FOV: 45 degrees, CFP, image size 2352x1568:
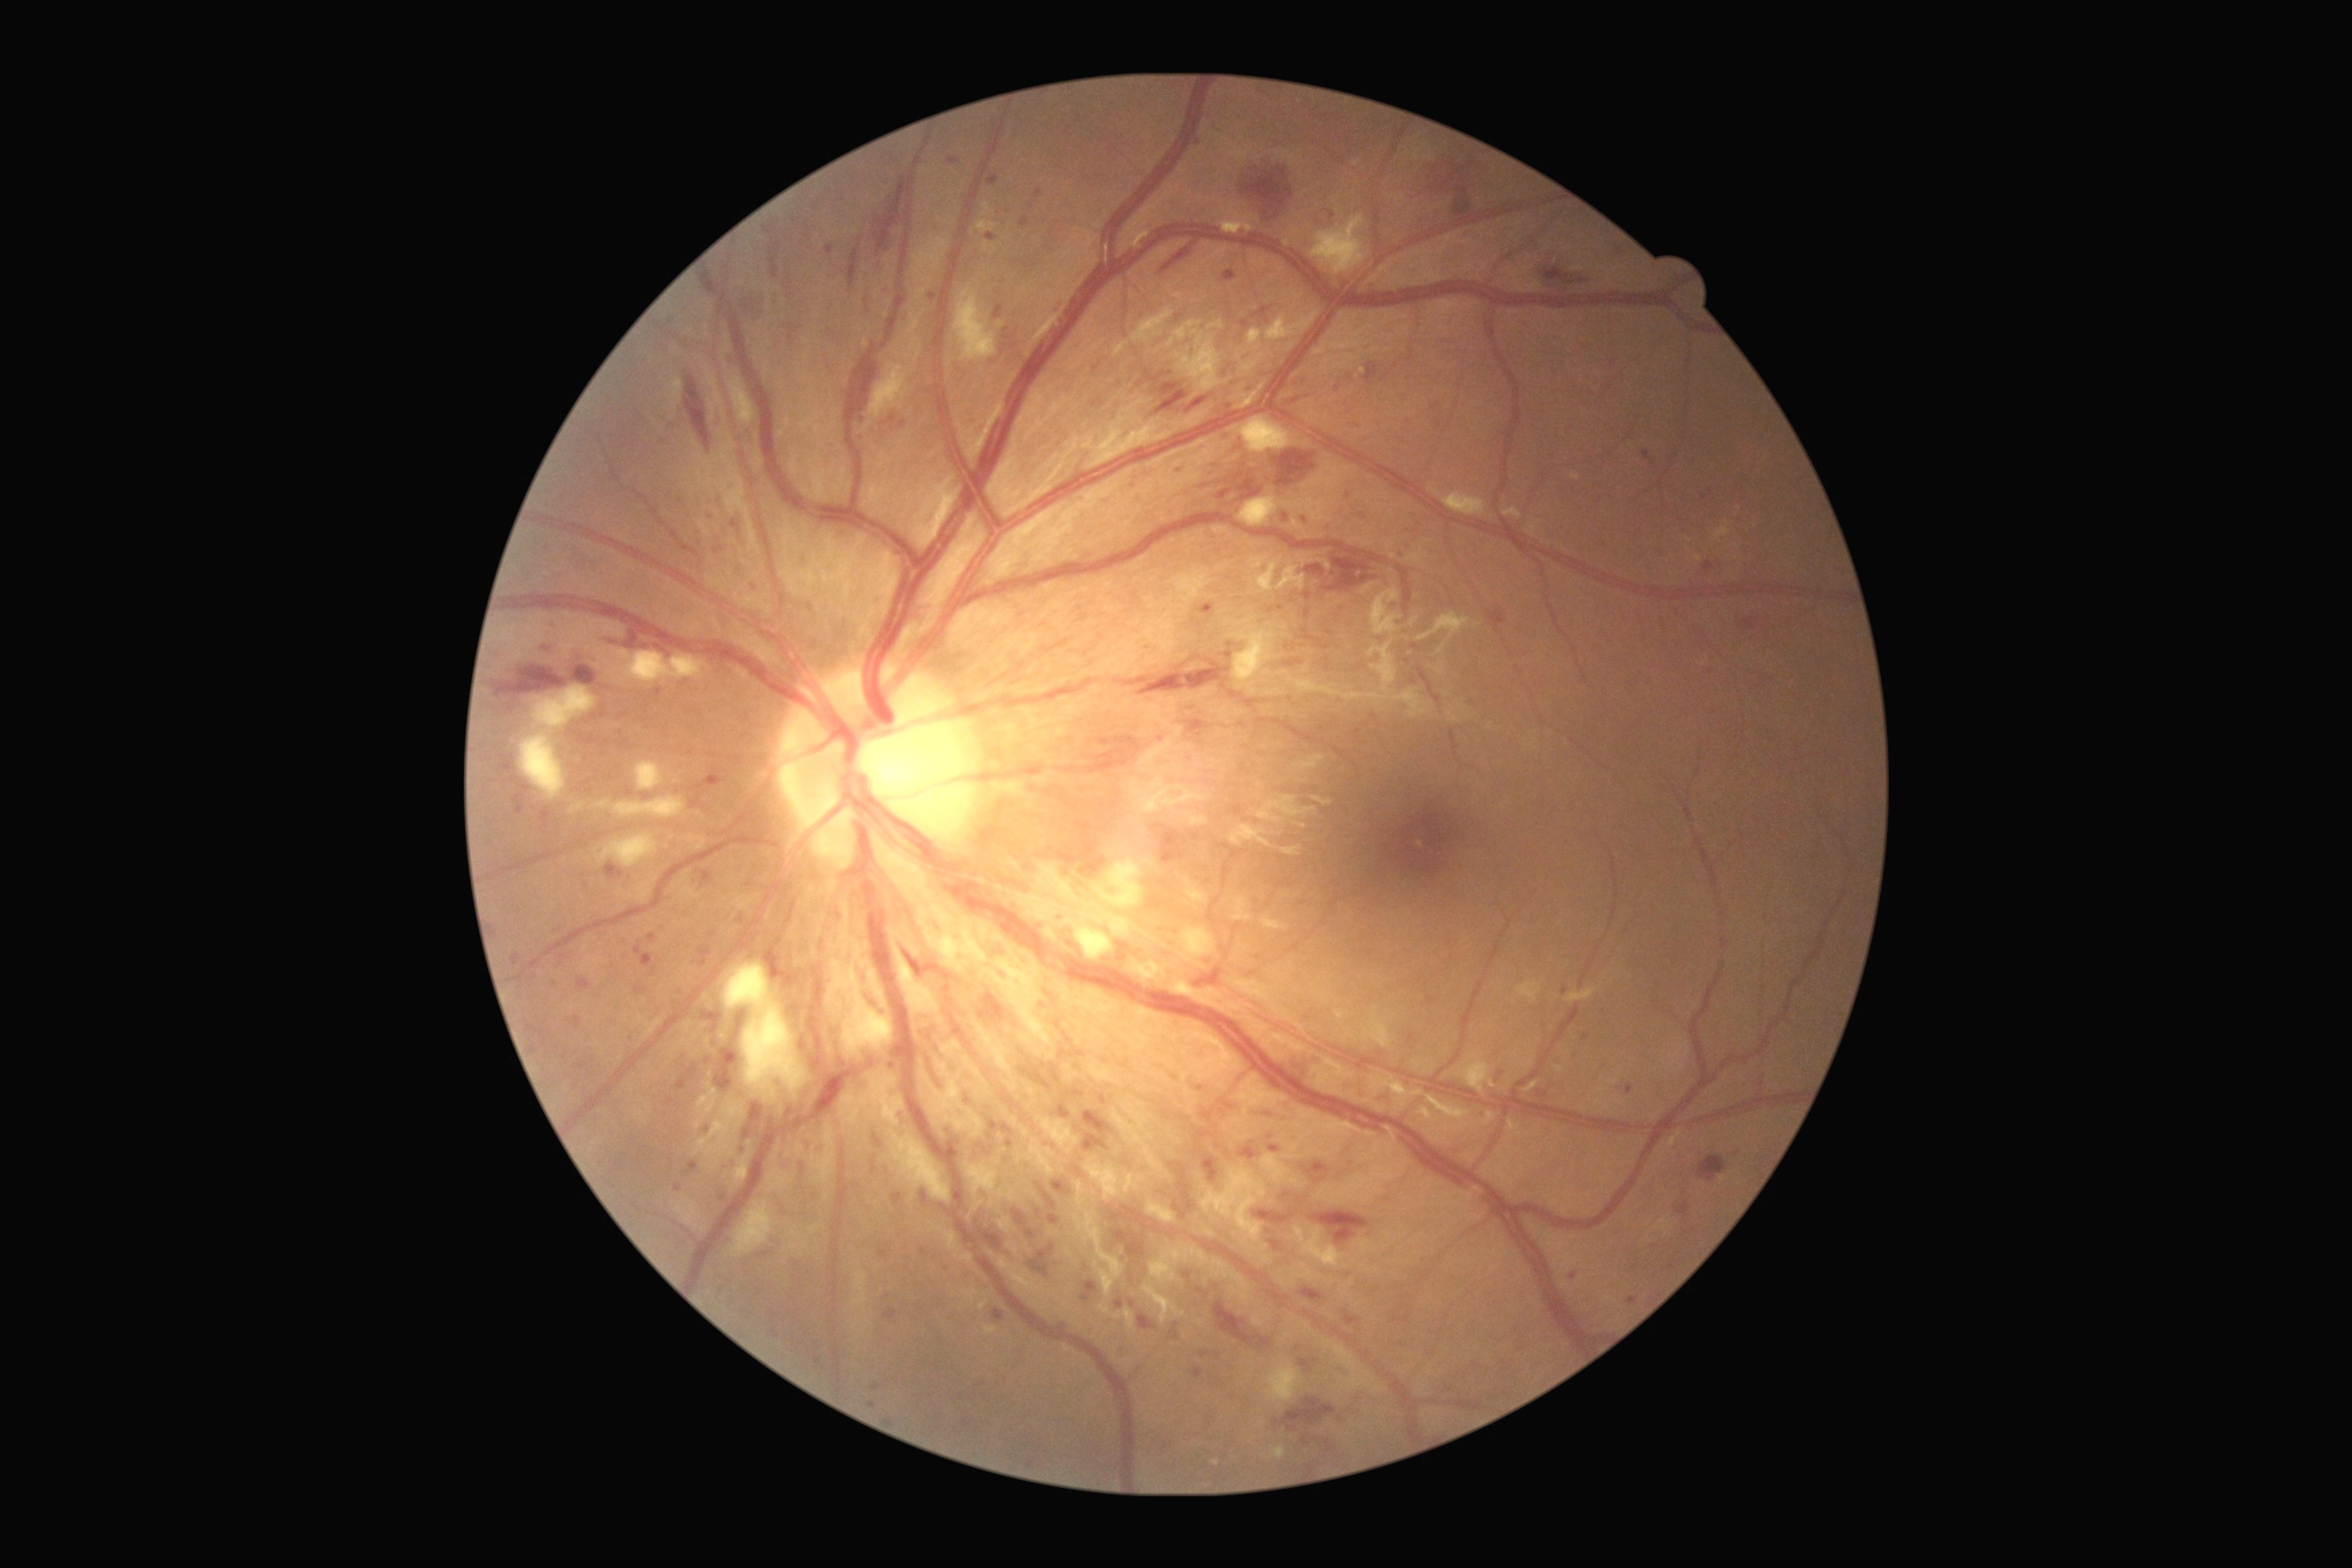

DR severity is severe NPDR (grade 3).
MAs include lesions at x1=634 y1=943 x2=654 y2=968; x1=868 y1=1402 x2=876 y2=1409; x1=995 y1=304 x2=1004 y2=318; x1=573 y1=652 x2=578 y2=662; x1=576 y1=1063 x2=589 y2=1070; x1=540 y1=810 x2=551 y2=828; x1=975 y1=1382 x2=986 y2=1389; x1=888 y1=416 x2=897 y2=424; x1=1240 y1=1142 x2=1259 y2=1161; x1=560 y1=956 x2=569 y2=959; x1=1300 y1=1358 x2=1311 y2=1373; x1=1199 y1=1130 x2=1211 y2=1139.
Small MAs near (1209,963); (861,1319); (1321,1180); (1198,142); (951,1132); (723,1198); (924,1252).